45° field of view · image size 2048x1536:
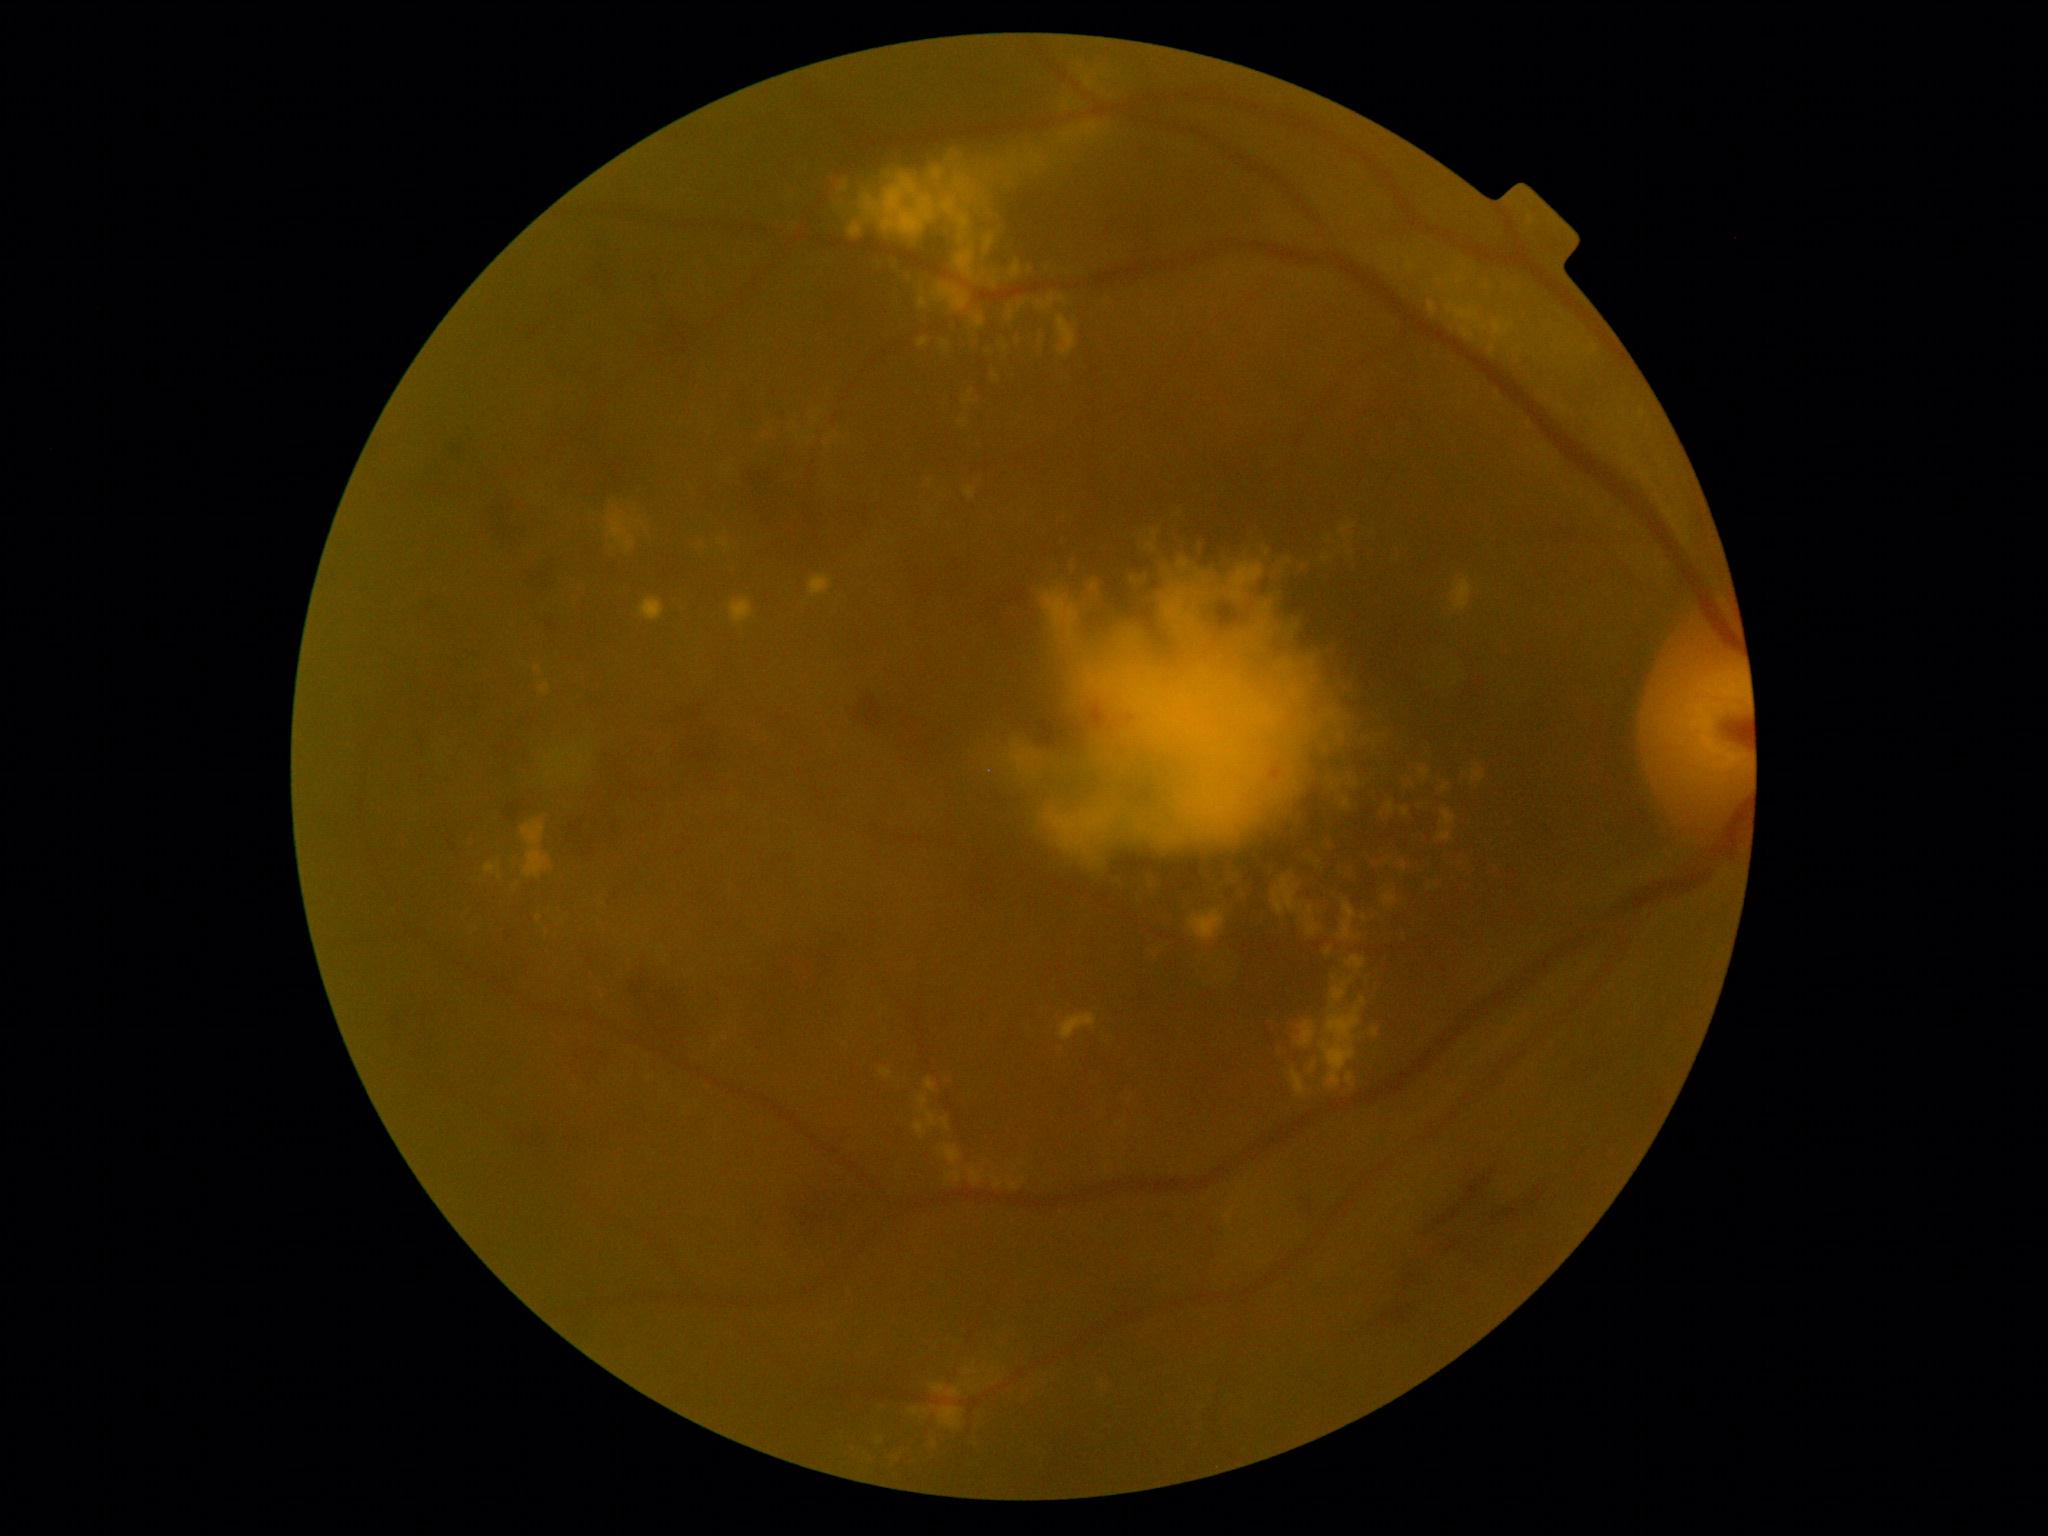 DR stage: moderate NPDR (grade 2); non-proliferative diabetic retinopathy.
EXs include 1330:647:1343:664 | 1142:867:1160:900 | 688:538:704:556 | 536:680:556:705 | 1373:1028:1378:1037 | 925:1078:937:1093 | 881:1070:893:1078 | 1058:295:1066:303 | 1235:883:1248:909 | 749:413:792:442 | 1355:779:1368:791 | 1492:320:1515:337 | 1011:740:1040:774 | 955:245:977:281 | 1373:859:1384:870 | 1327:750:1357:810.
Small EXs approximately at {"x": 820, "y": 411} | {"x": 995, "y": 376}.